Modified Davis classification.
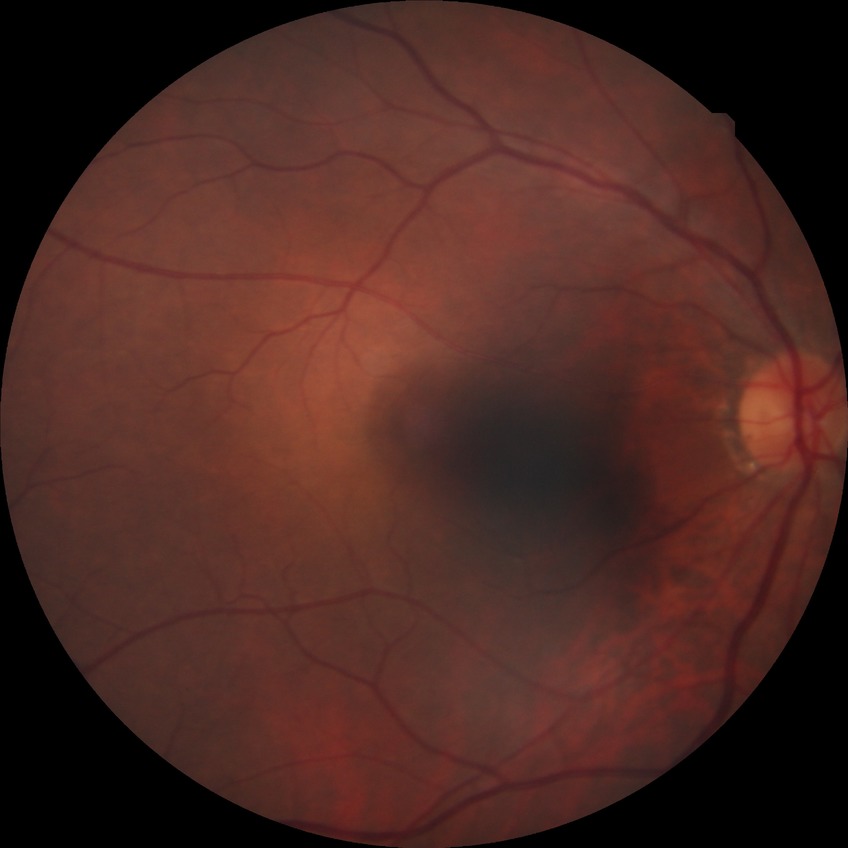
Findings:
* modified Davis classification — no diabetic retinopathy